Camera: Nidek AFC-330 — 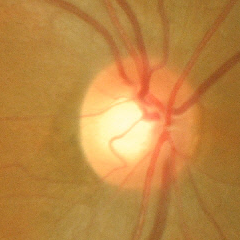 No glaucoma.